848x848
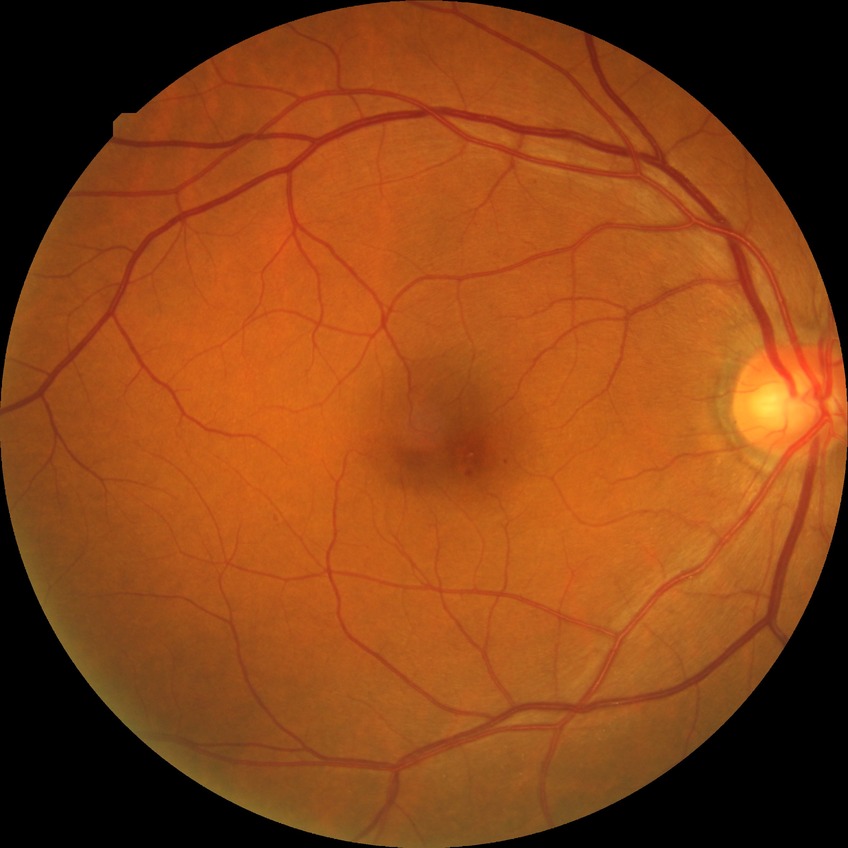
Diabetic retinopathy (DR) is simple diabetic retinopathy (SDR). The retinopathy is classified as non-proliferative diabetic retinopathy.